Graded on the modified Davis scale; 848 by 848 pixels; nonmydriatic.
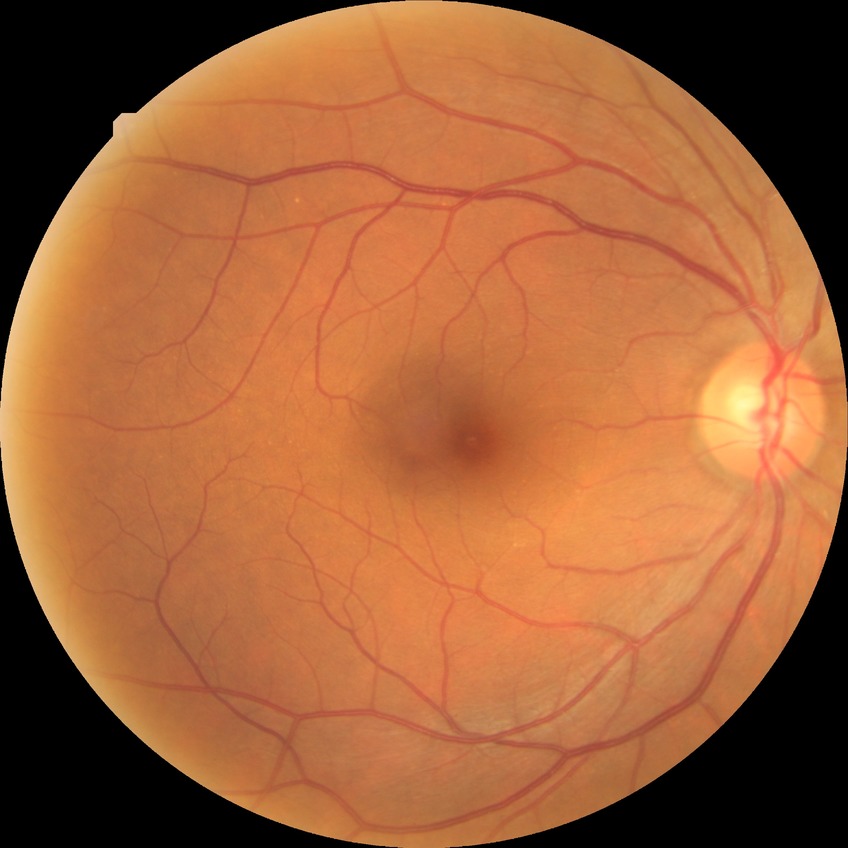 Davis grade is NDR.